CFP
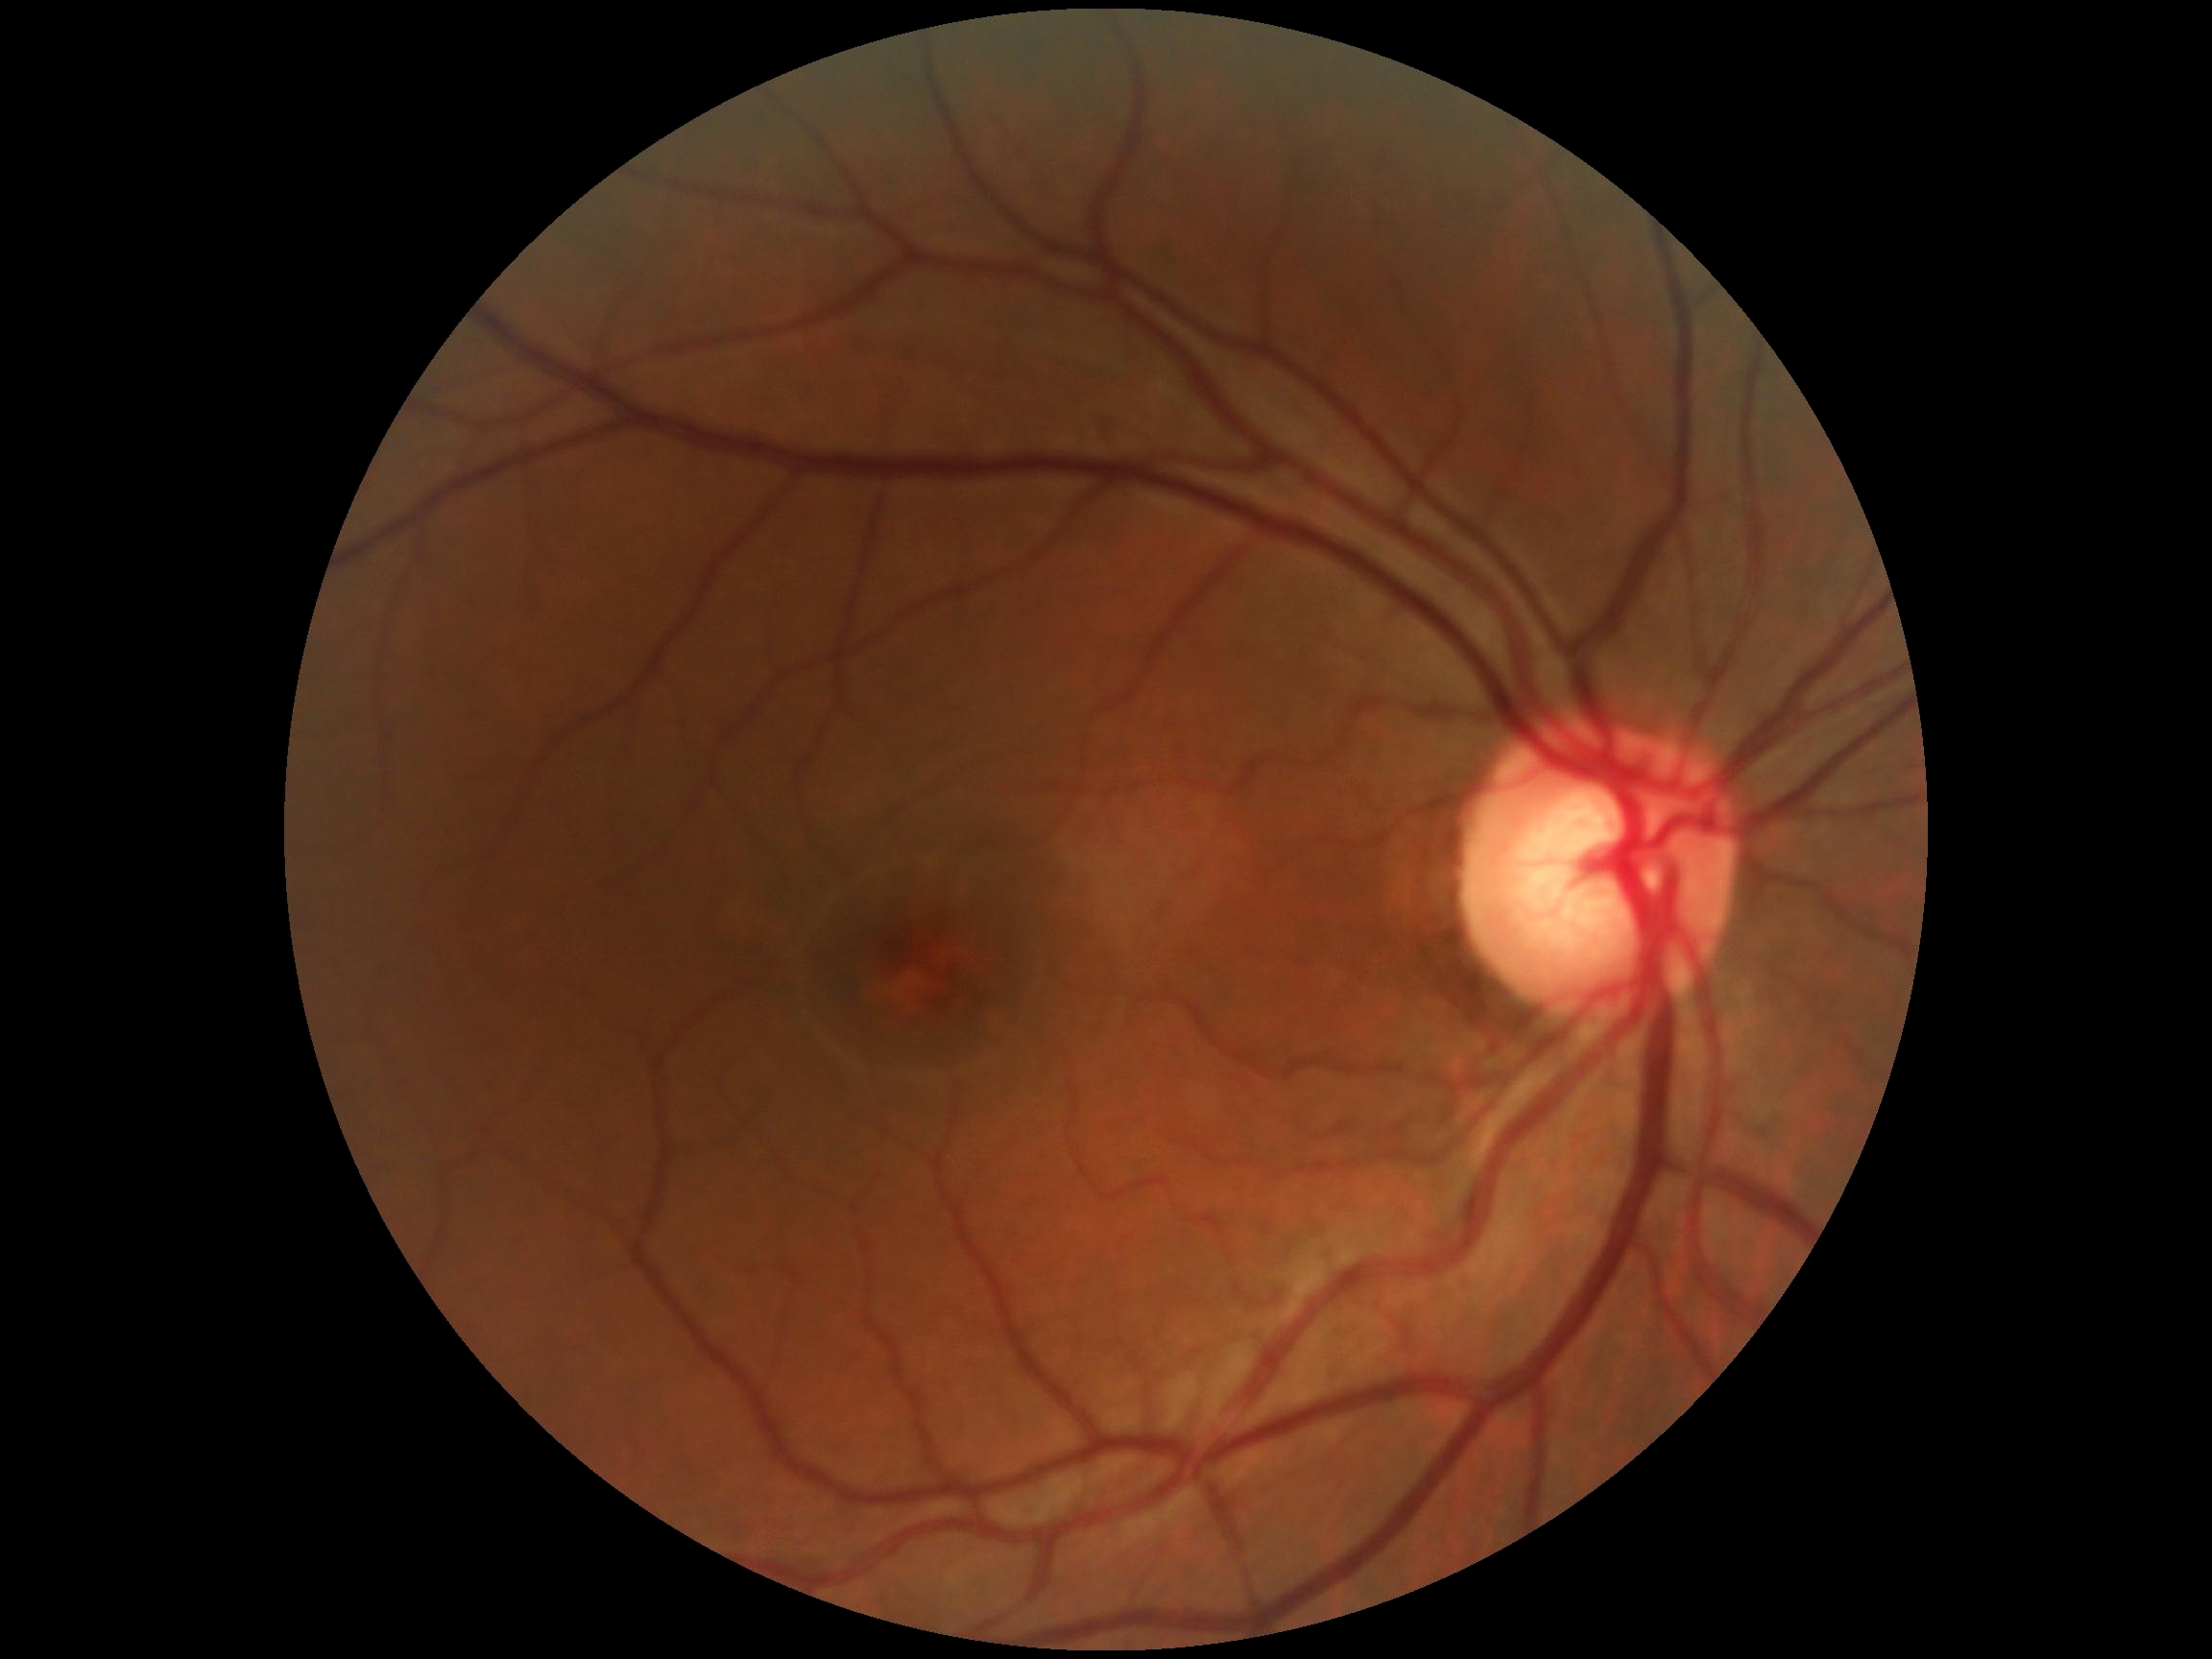 Retinopathy is no apparent diabetic retinopathy (grade 0).